Nonmydriatic fundus photograph. 45° field of view — 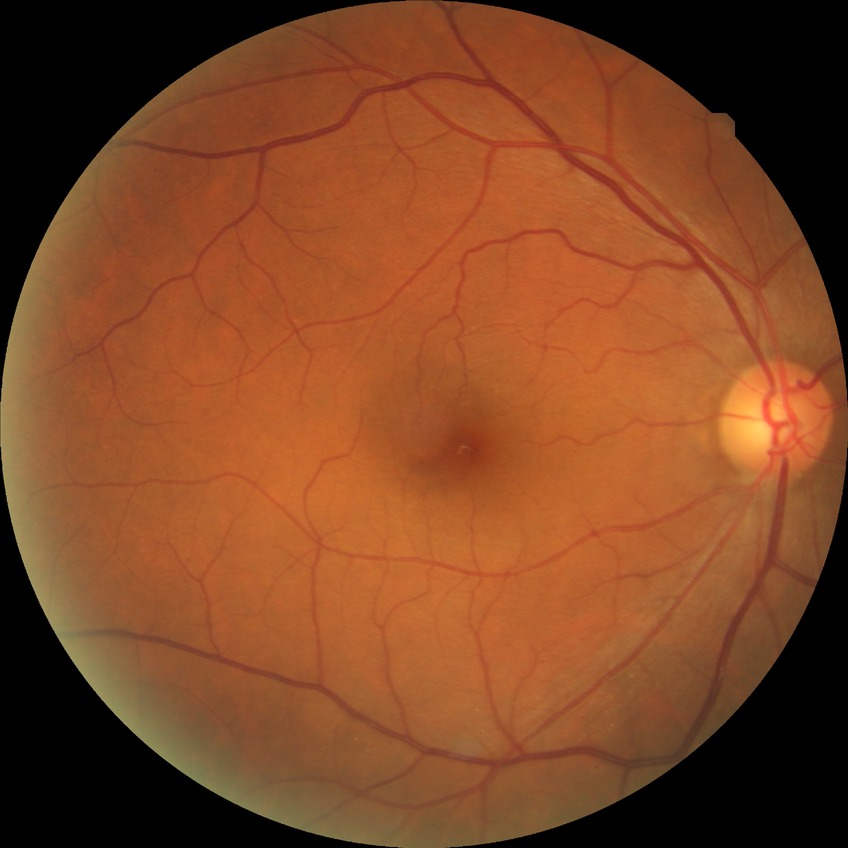

Diabetic retinopathy (DR): no diabetic retinopathy (NDR).